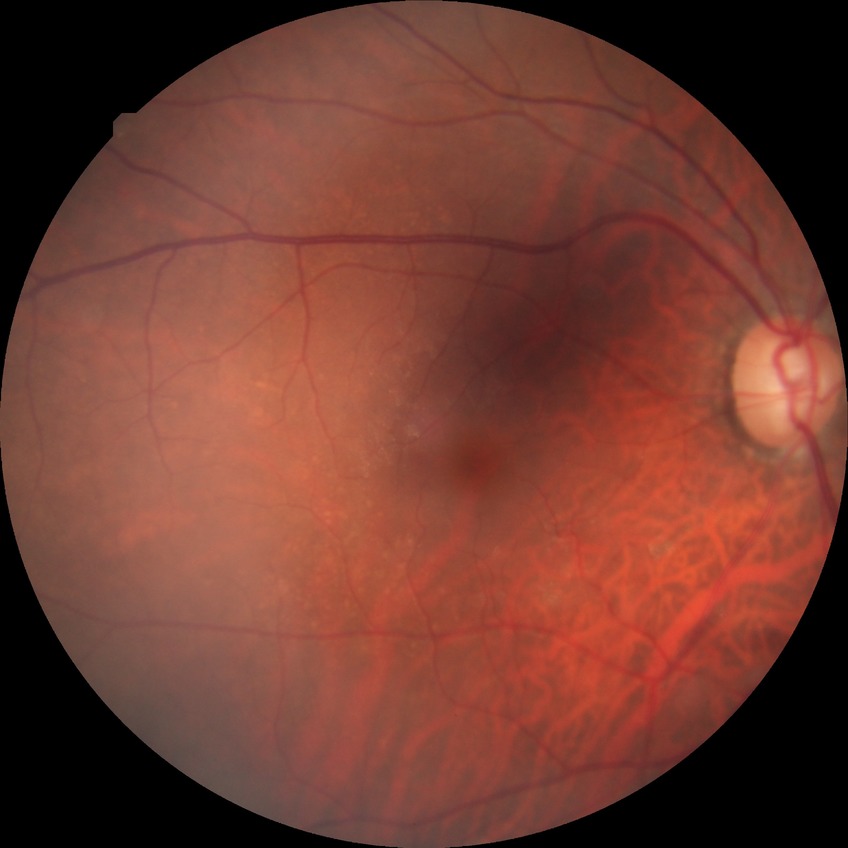 Diabetic retinopathy grade: no diabetic retinopathy.